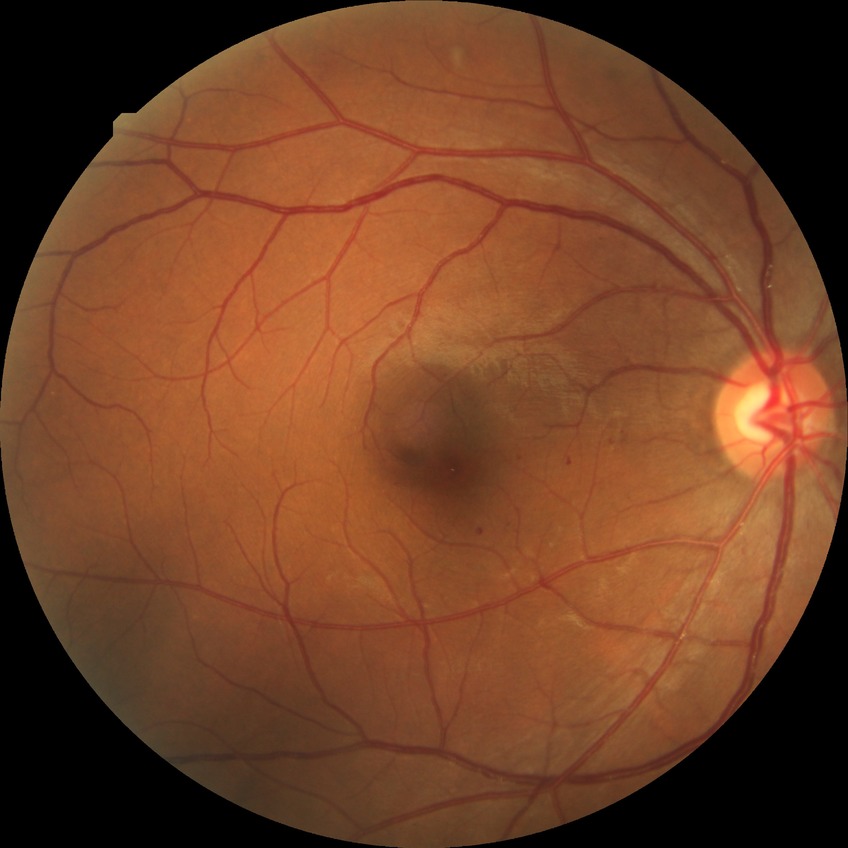 Diabetic retinopathy severity is simple diabetic retinopathy.